Infant wide-field retinal image · 1240 by 1240 pixels.
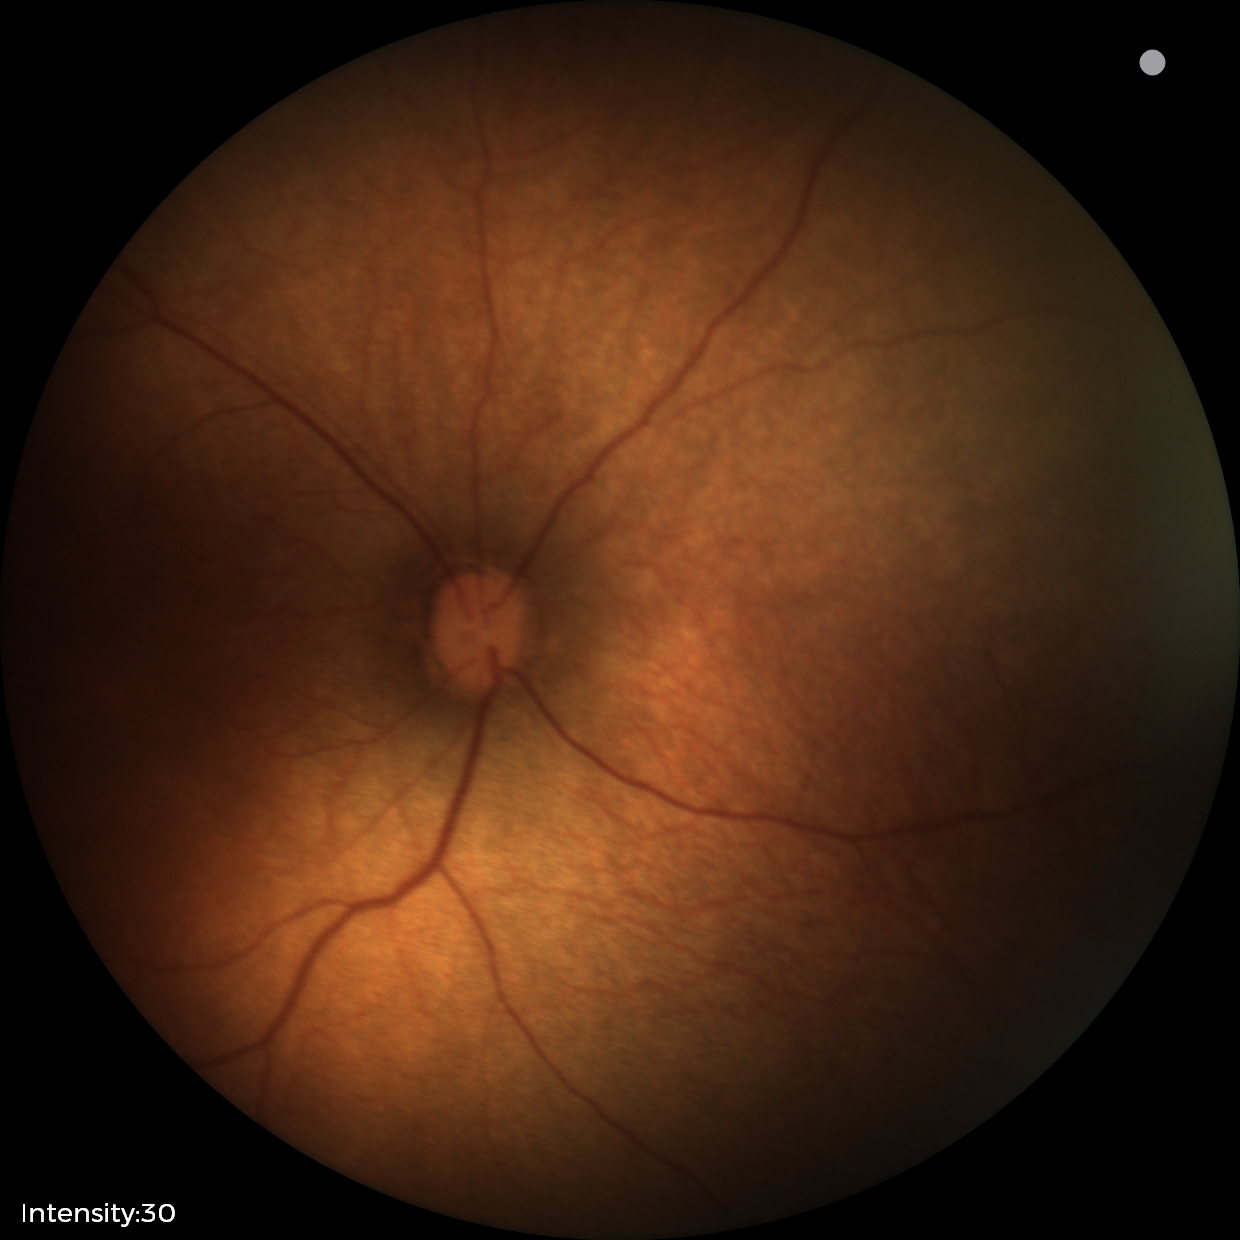
Assessment: physiological finding.